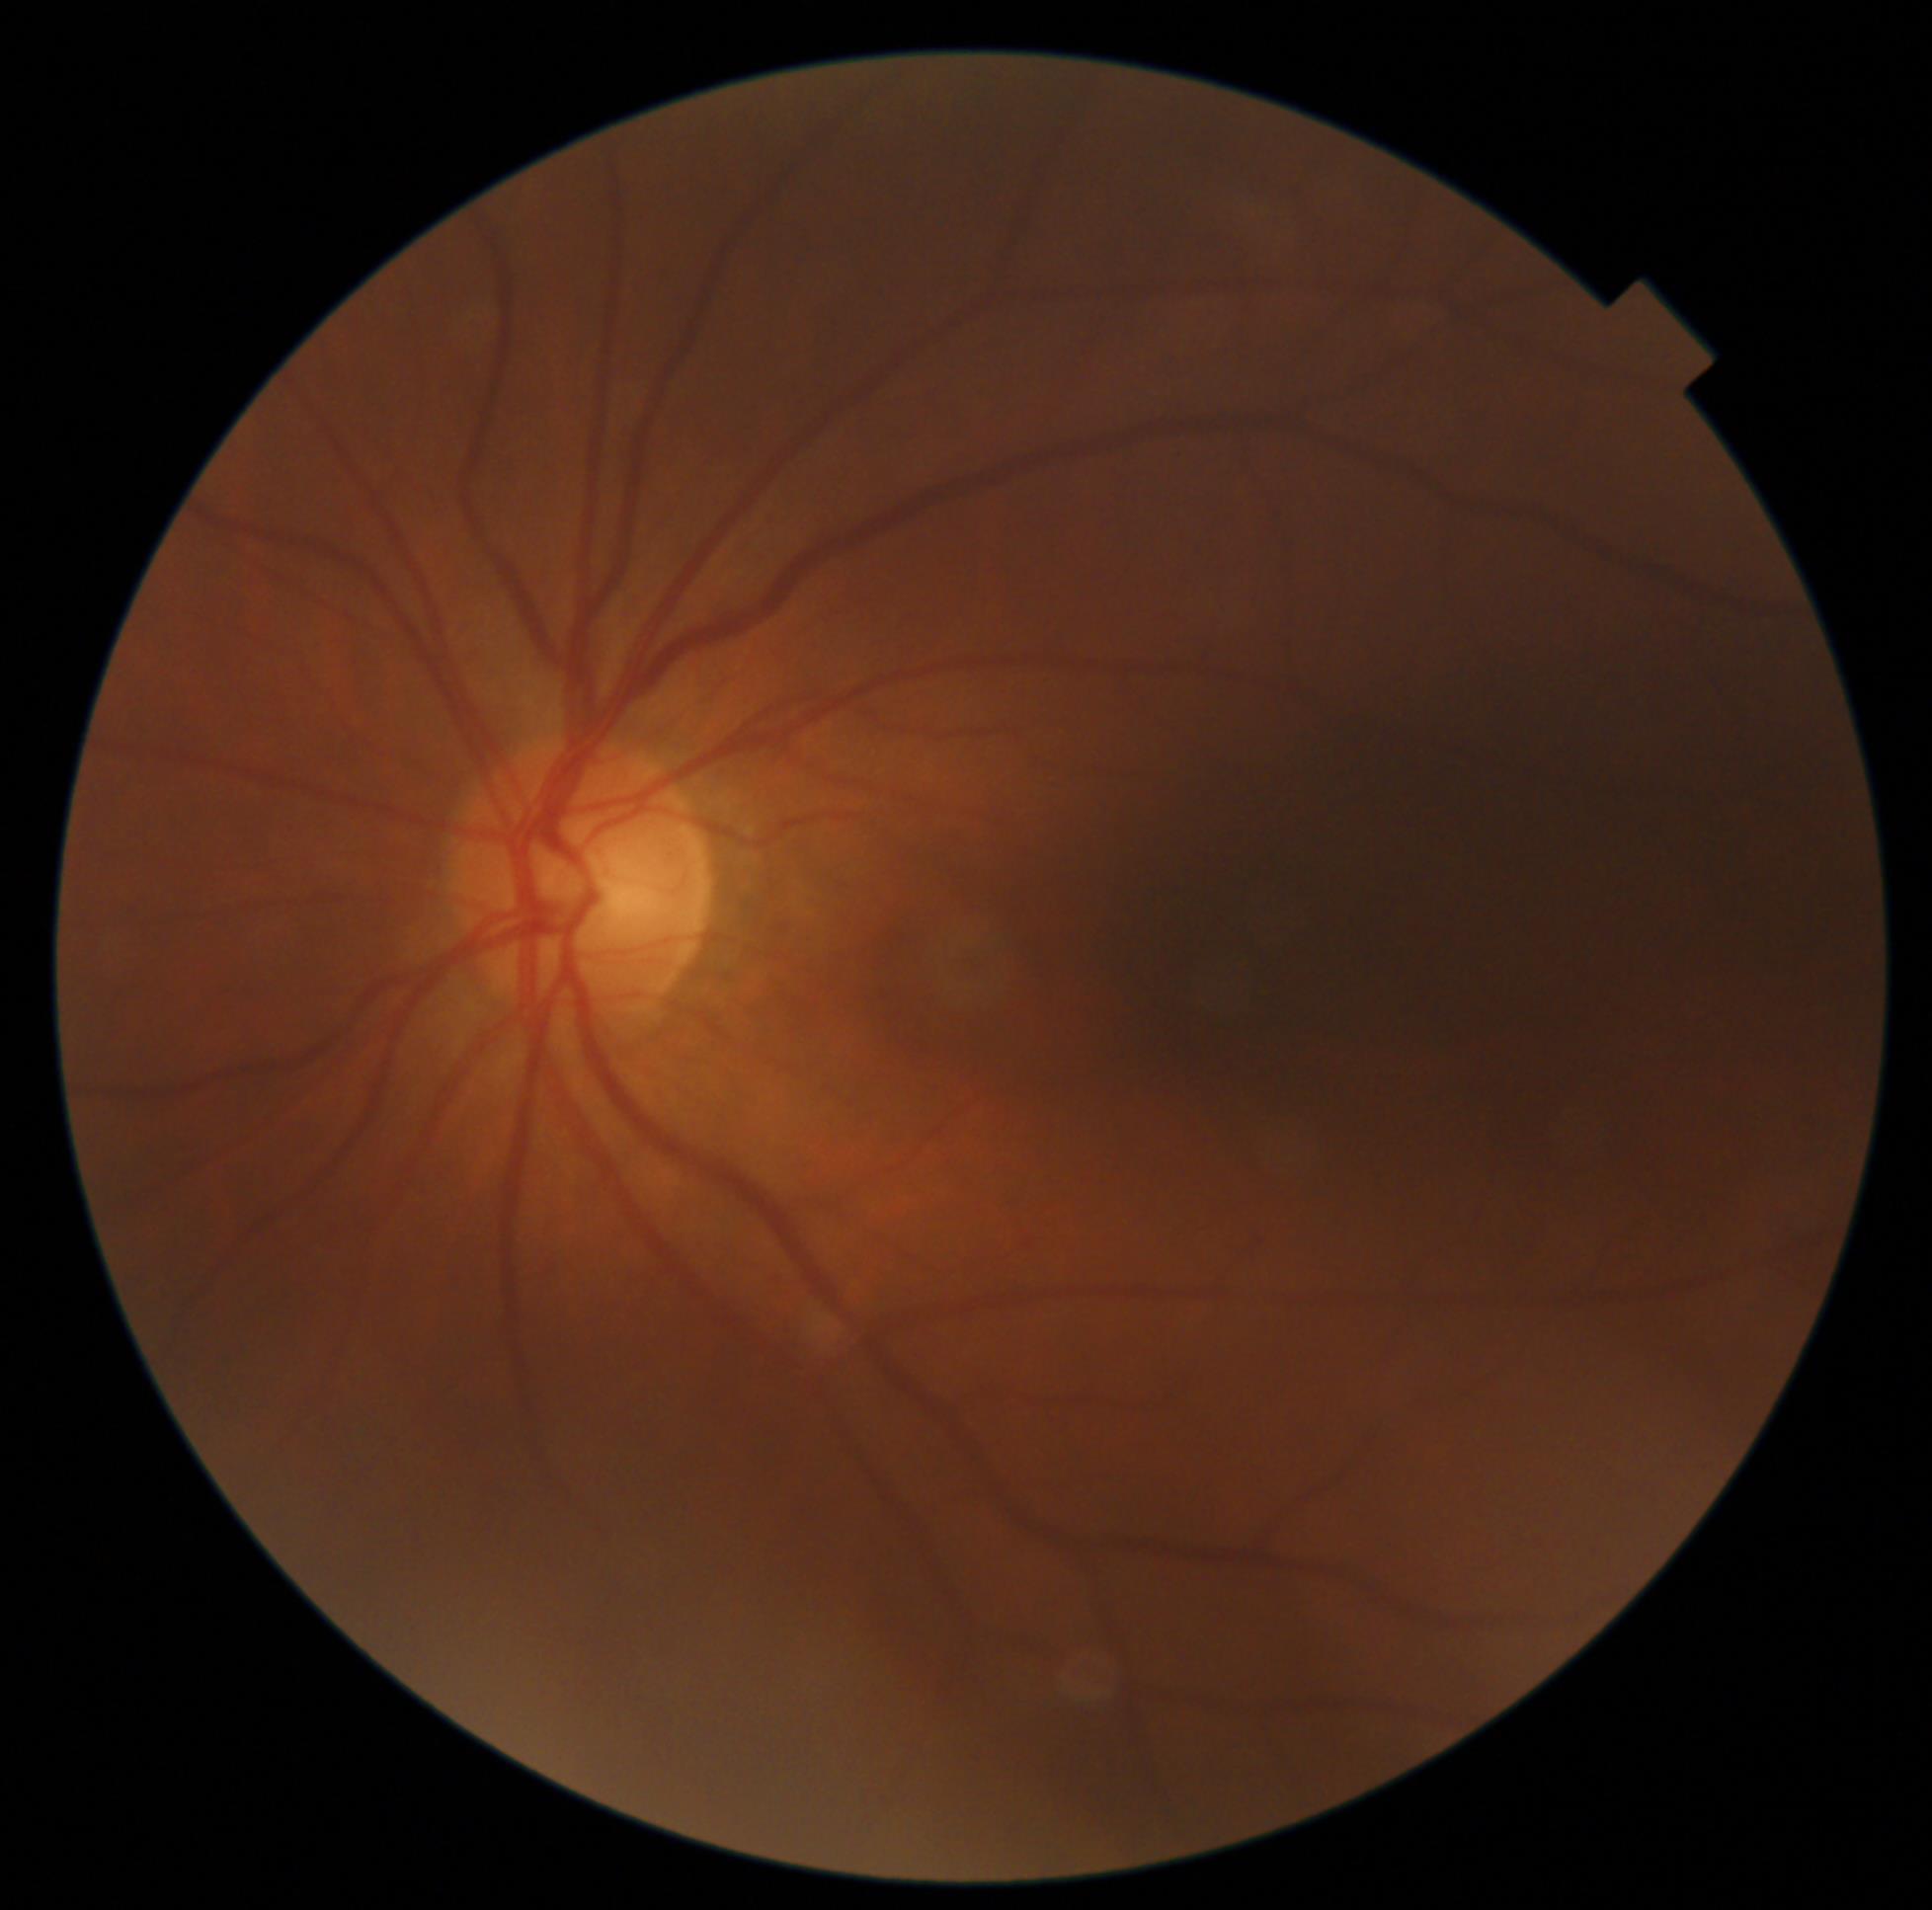
DR severity = 0/4.